Ultra-widefield fundus mosaic. Image size 1924x1556 — 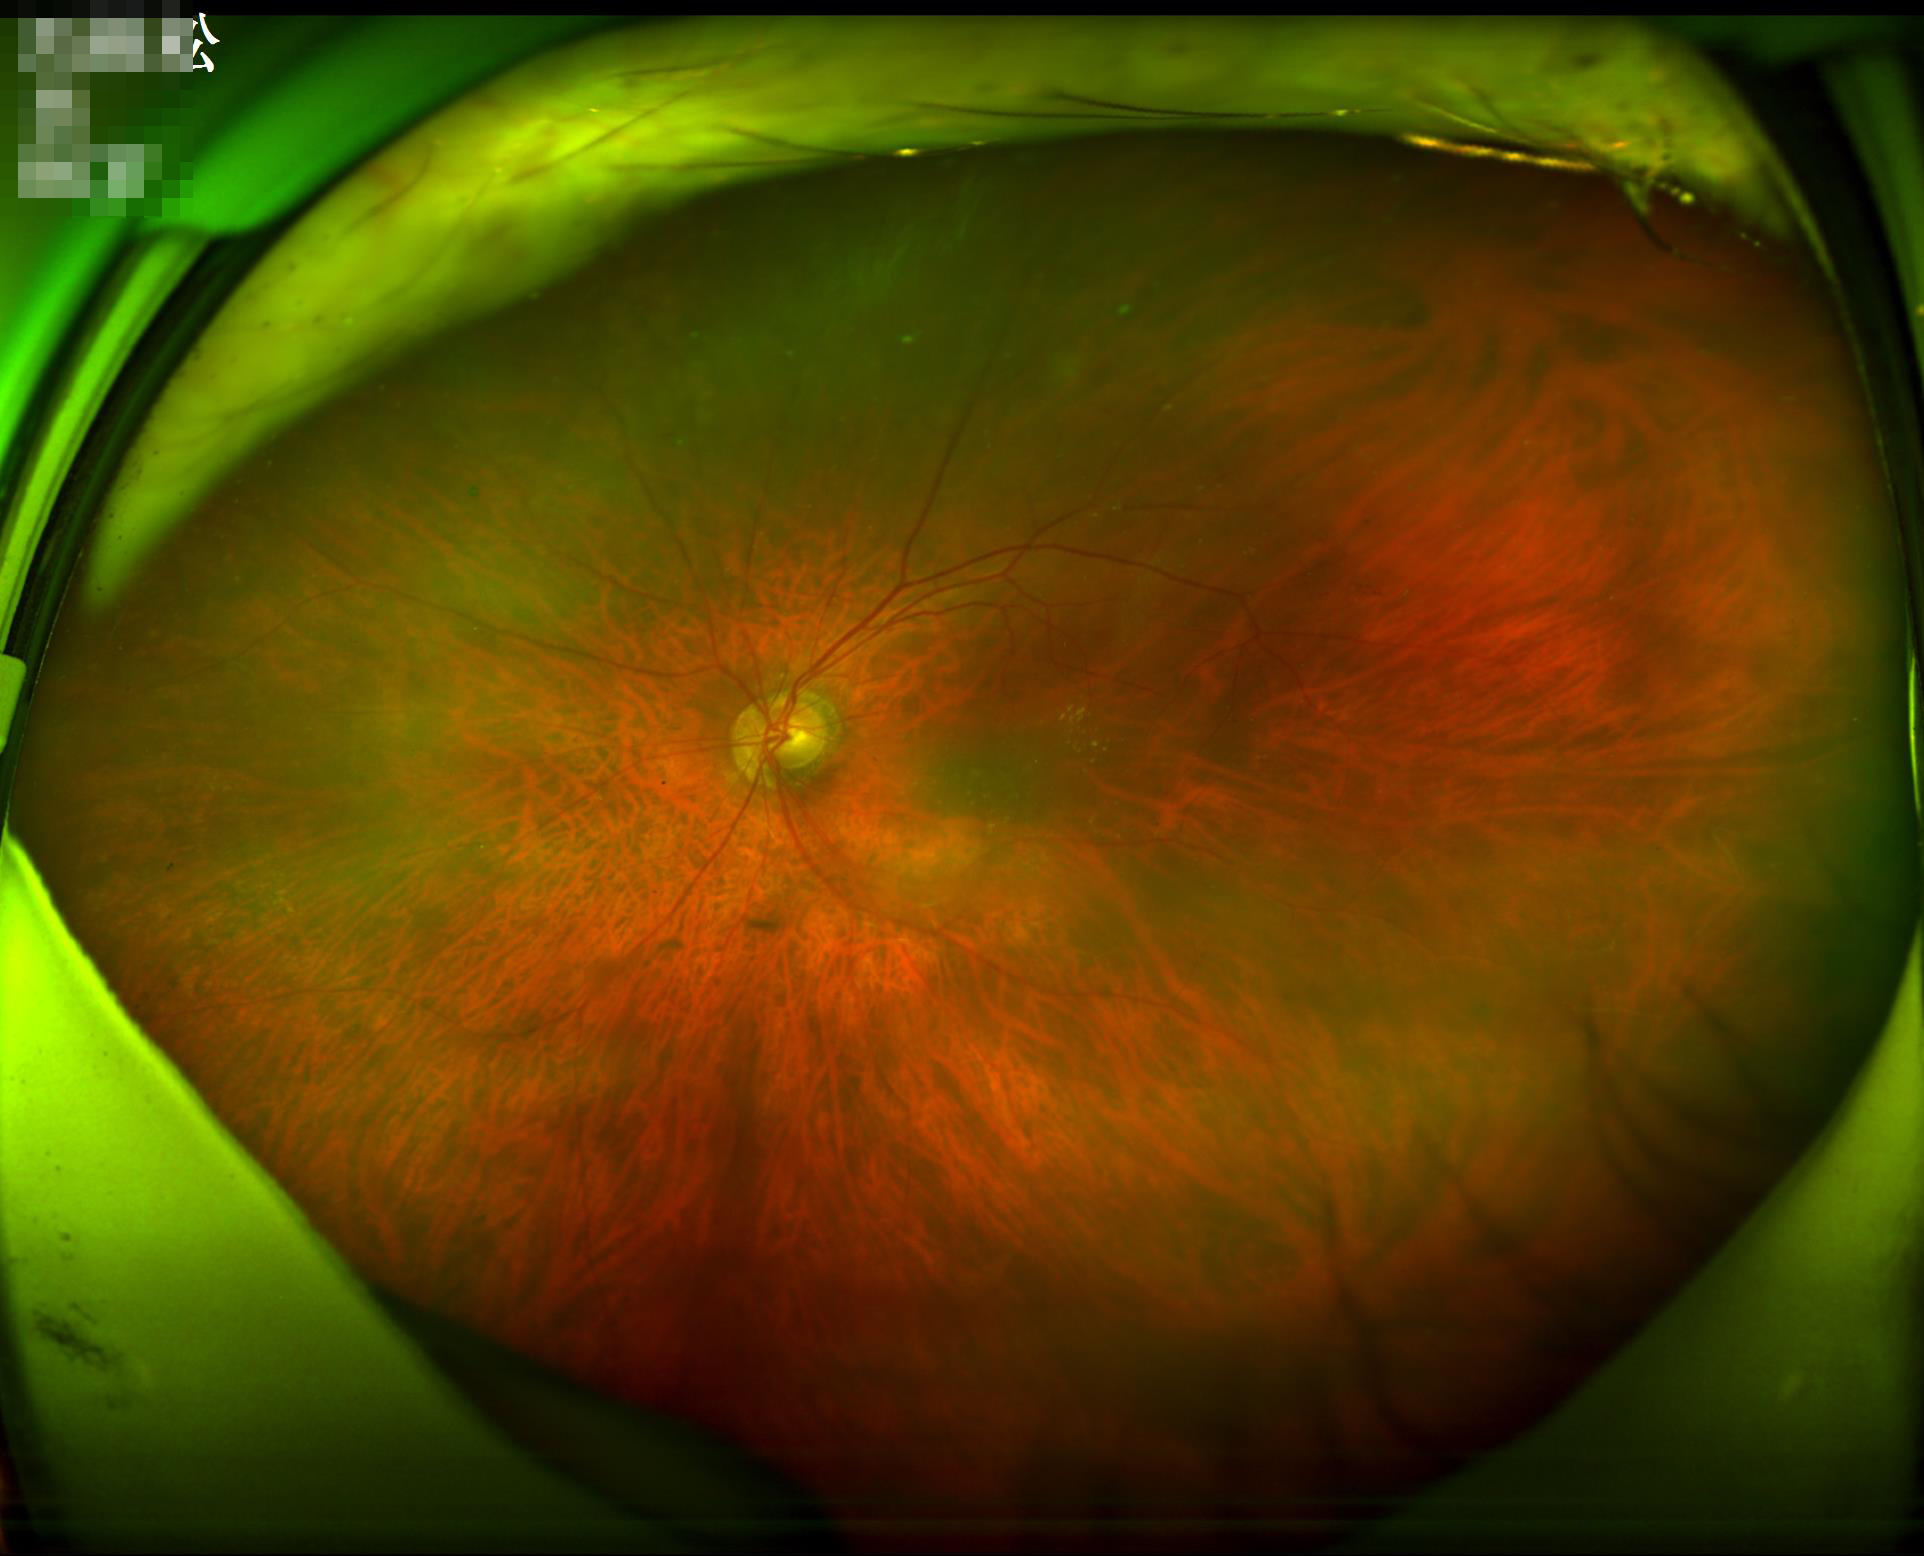

Quality assessment:
- contrast: satisfactory
- illumination/color: adequate
- focus: good